Optic disc region crop; color fundus image; non-mydriatic fundus camera.
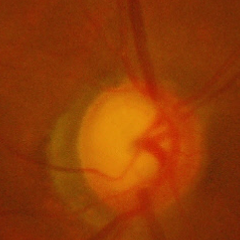

Severe glaucomatous damage.